Modified Davis classification: 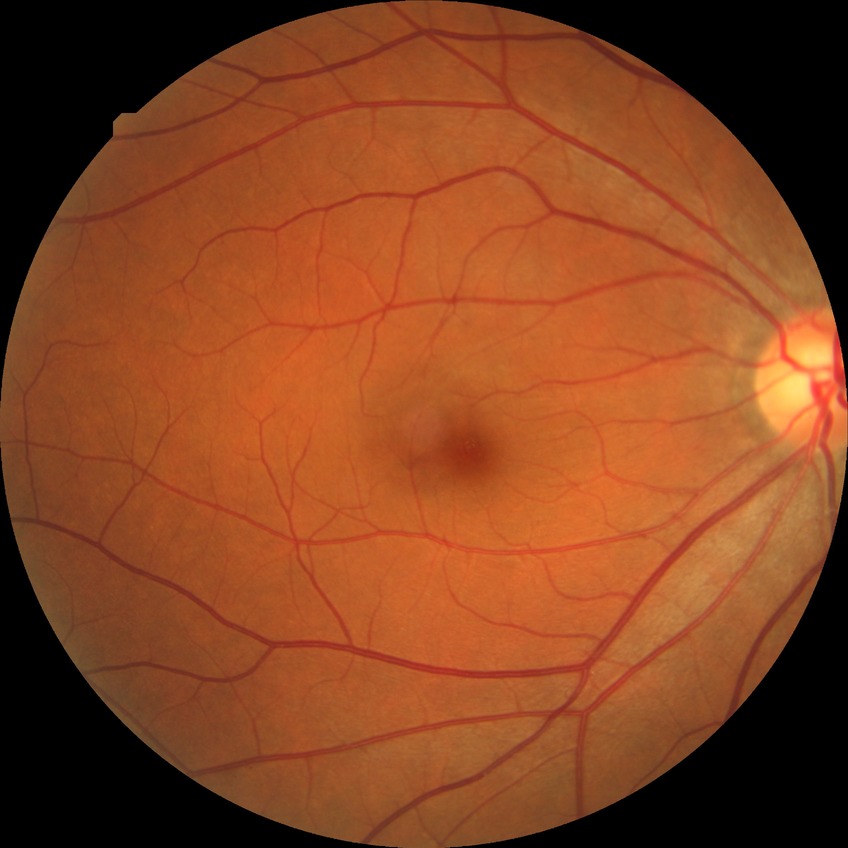
diabetic retinopathy (DR) = NDR (no diabetic retinopathy)